Color fundus photograph
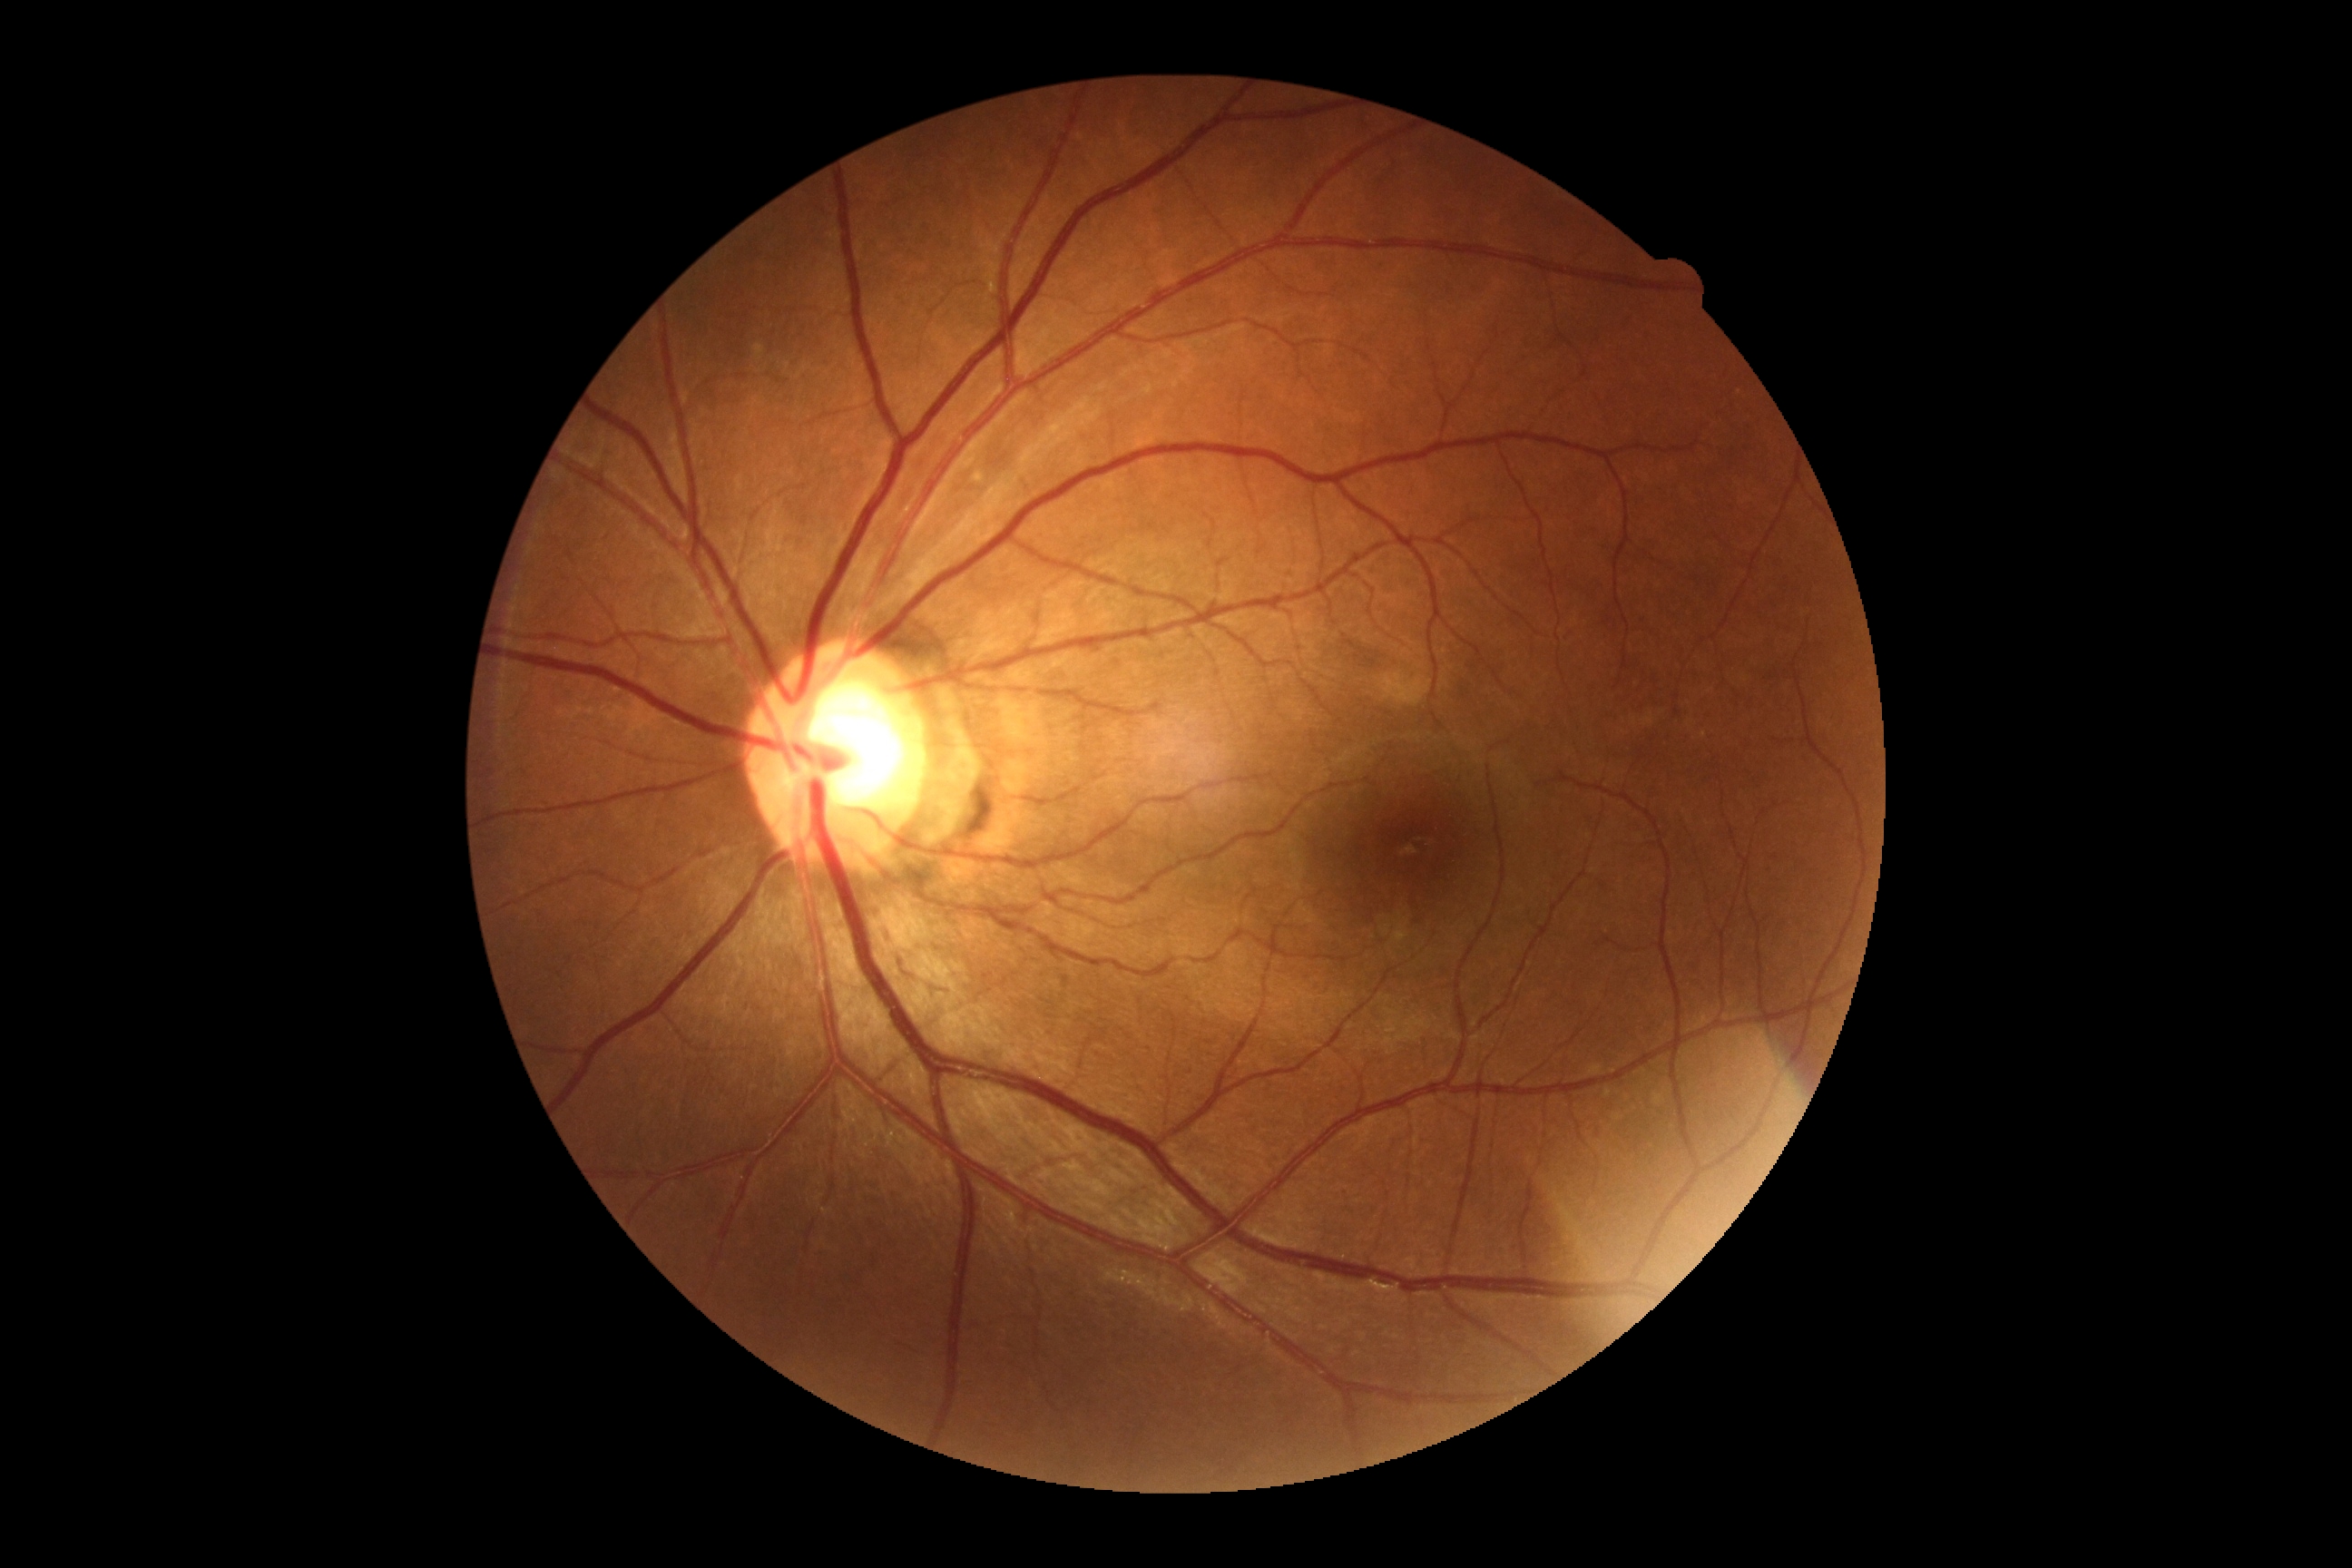 {
  "dr_grade": "0/4",
  "dr_impression": "no apparent DR"
}